640 x 480 pixels. Pediatric retinal photograph (wide-field).
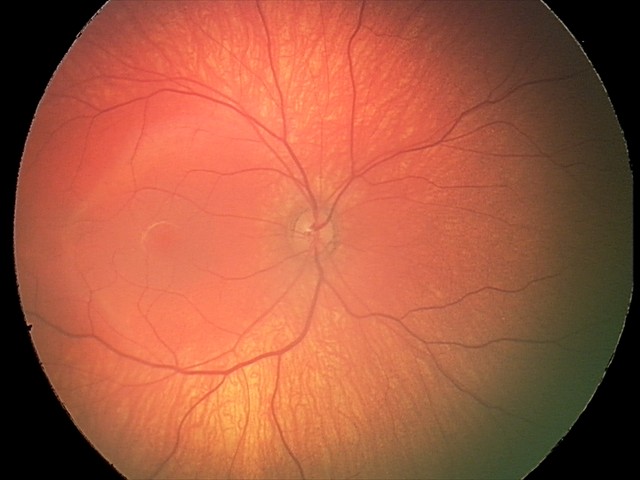

No retinal pathology identified on screening.